45° FOV, CFP.
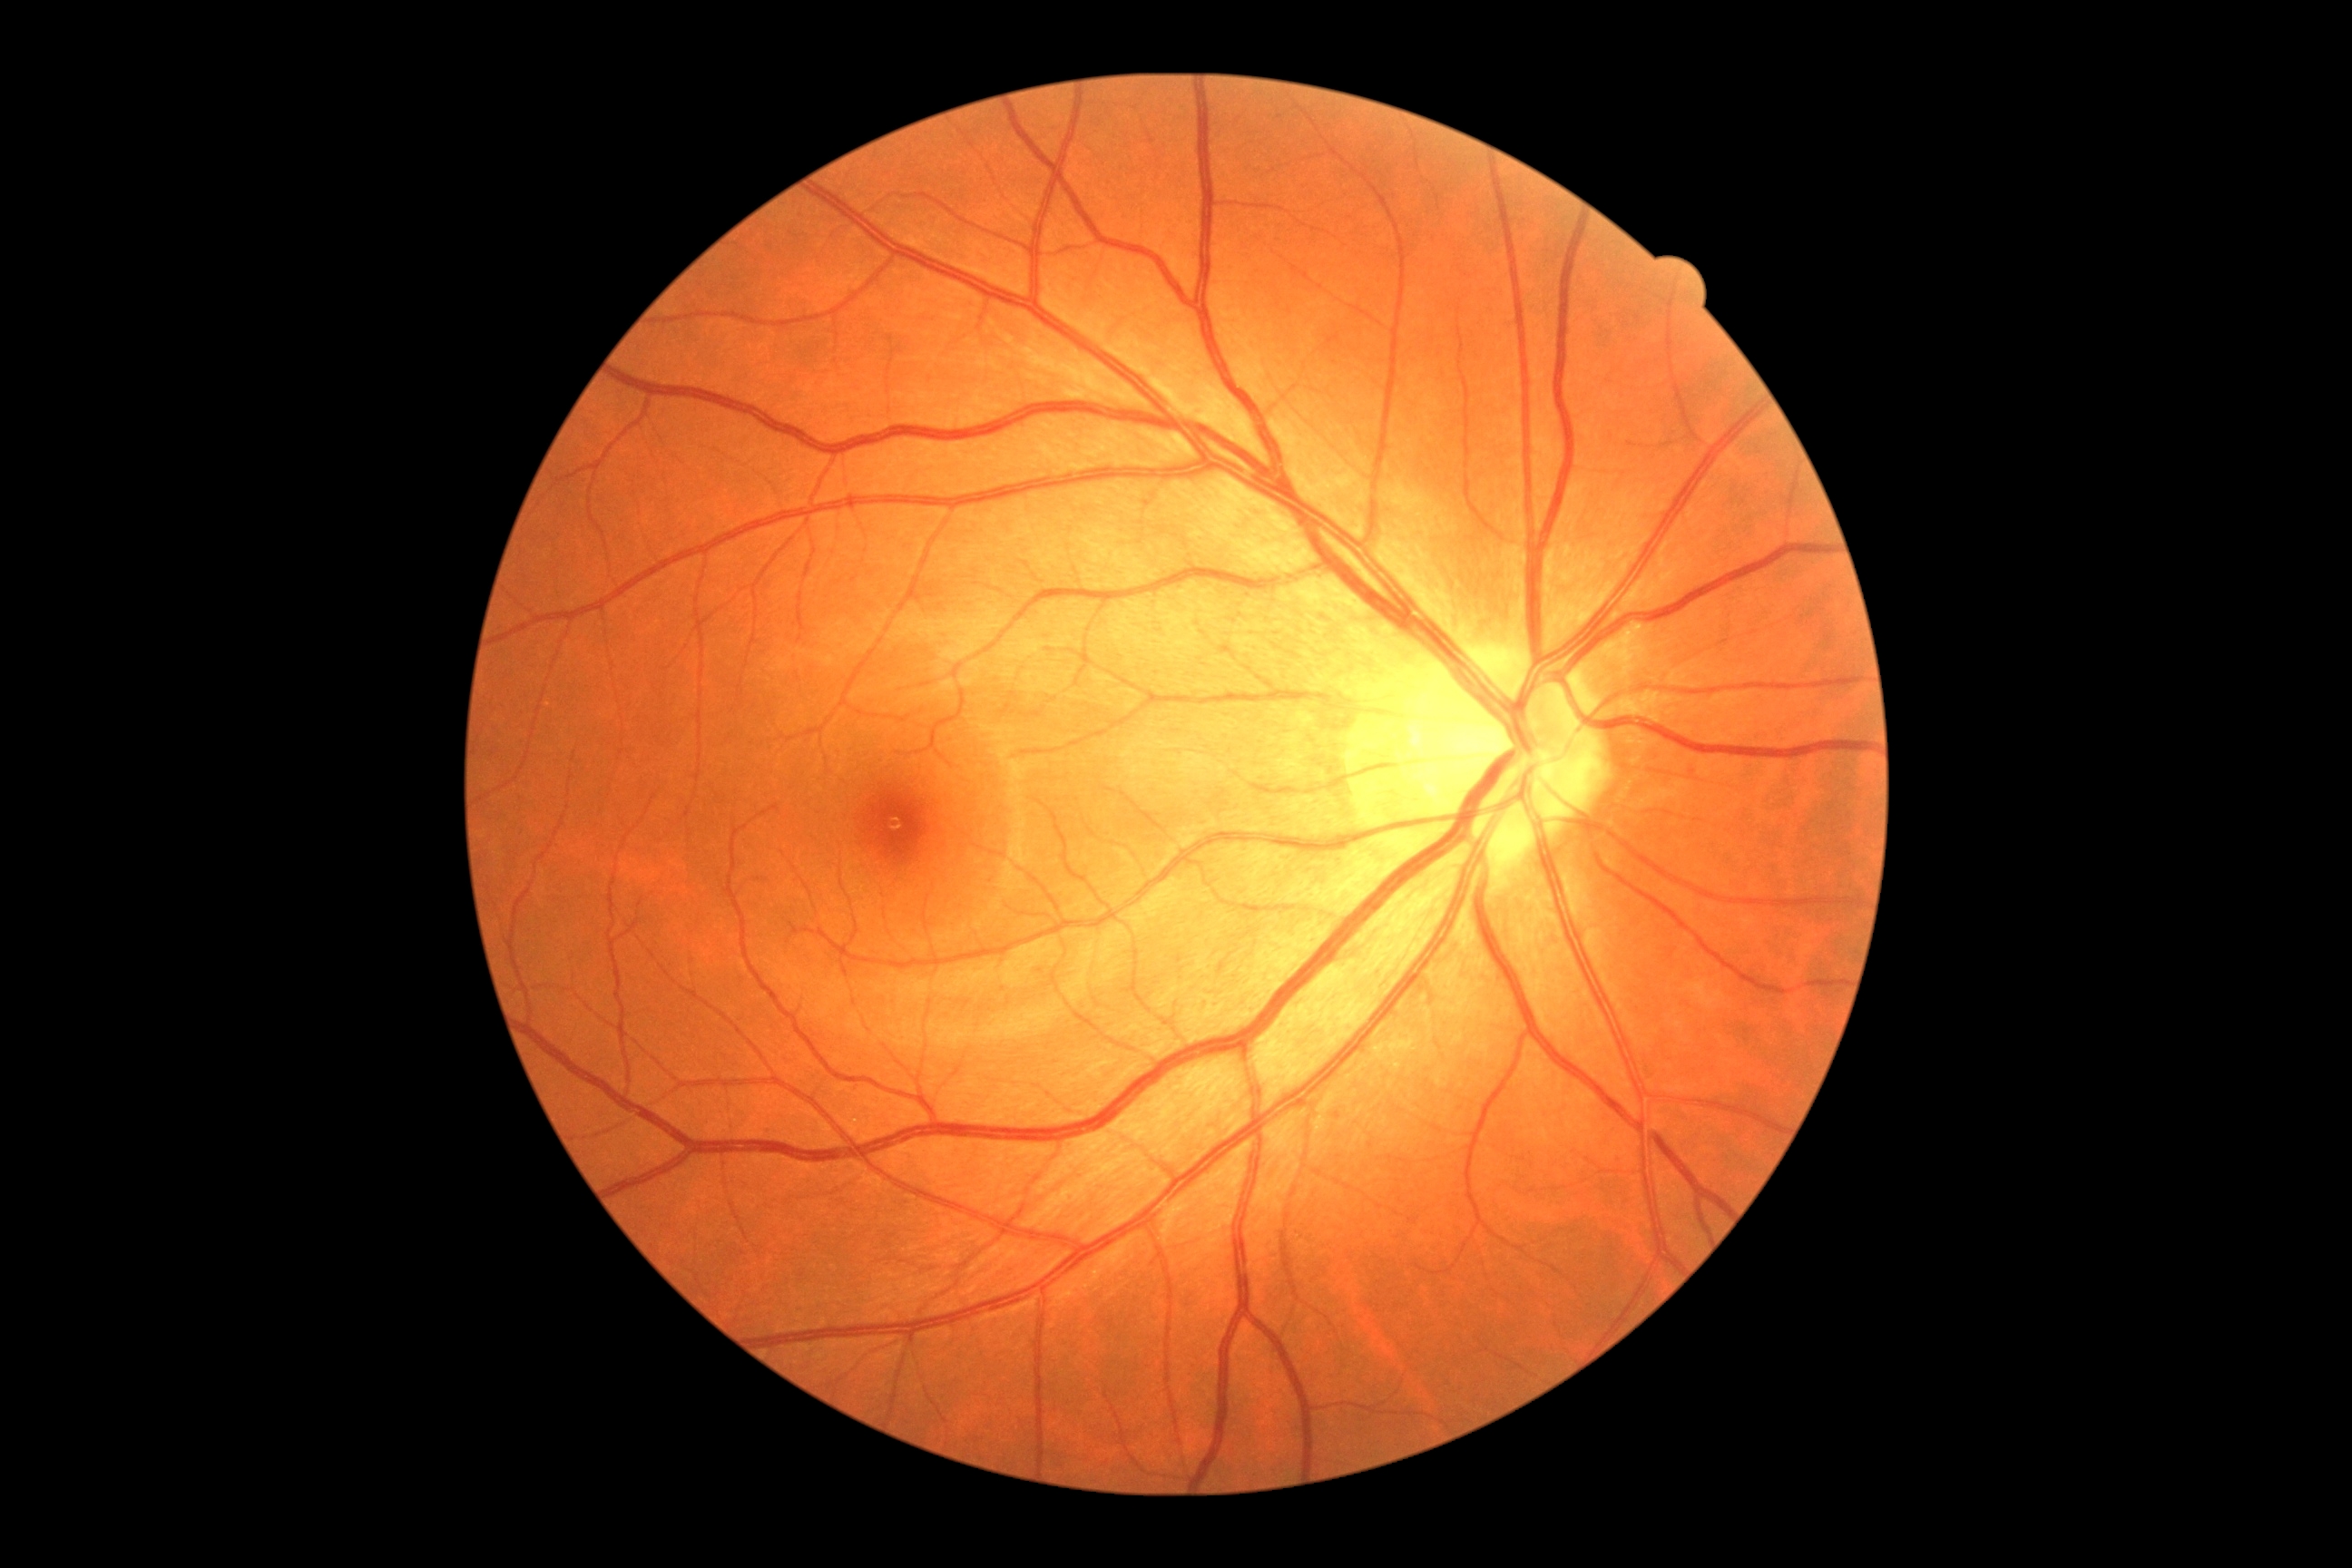 Diabetic retinopathy (DR): 0/4.